Wide-field fundus photograph of an infant: 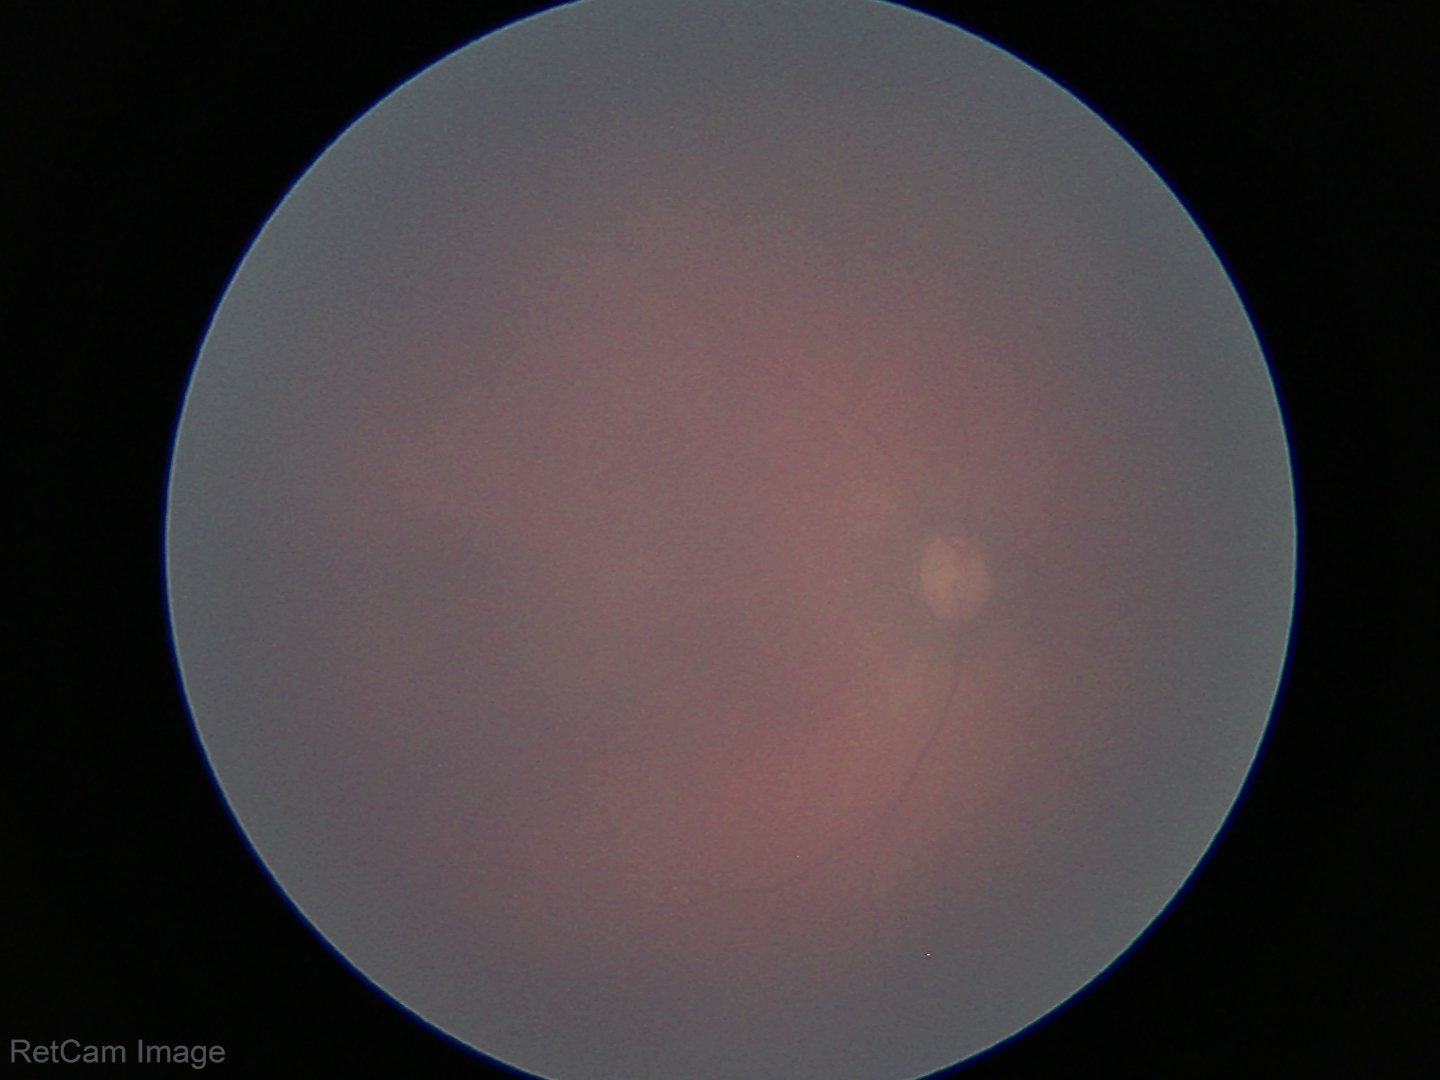 Impression: normal retinal appearance.